240 by 240 pixels. Optic disc region crop — 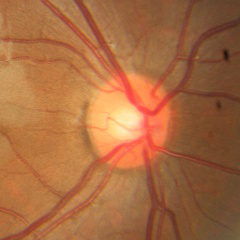
Q: What stage of glaucoma is present?
A: No — no glaucoma.